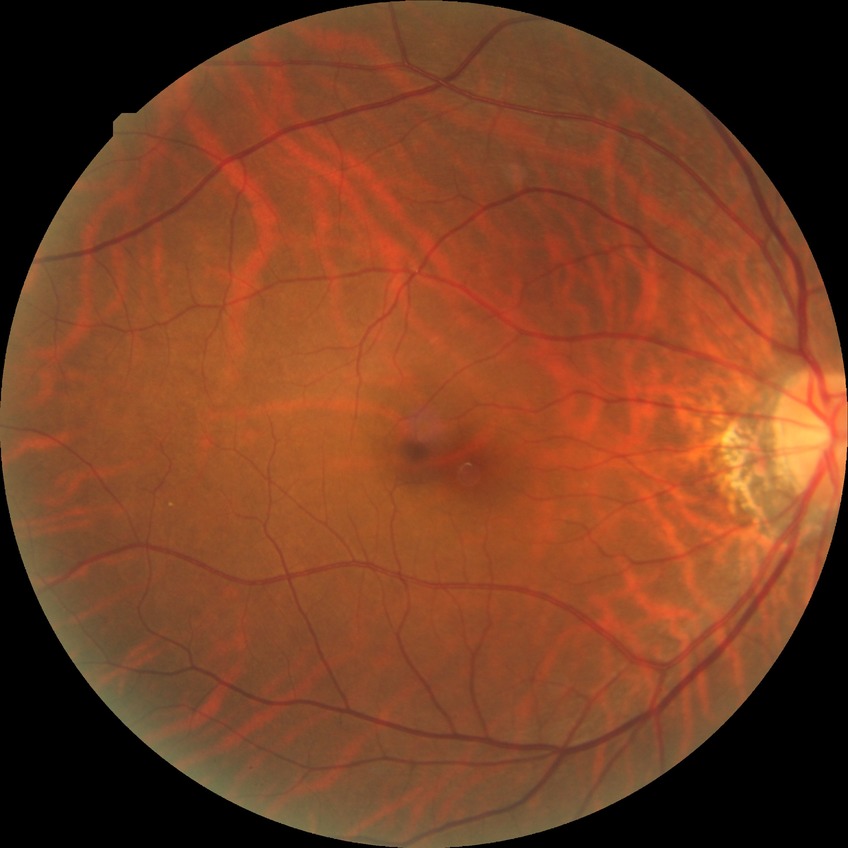 {
  "davis_grade": "no diabetic retinopathy (NDR)"
}